Acquired with a Topcon TRC-50DX. 2228 x 1652 pixels. Posterior pole view. Fundus photo. FOV: 50 degrees. Pupil-dilated.
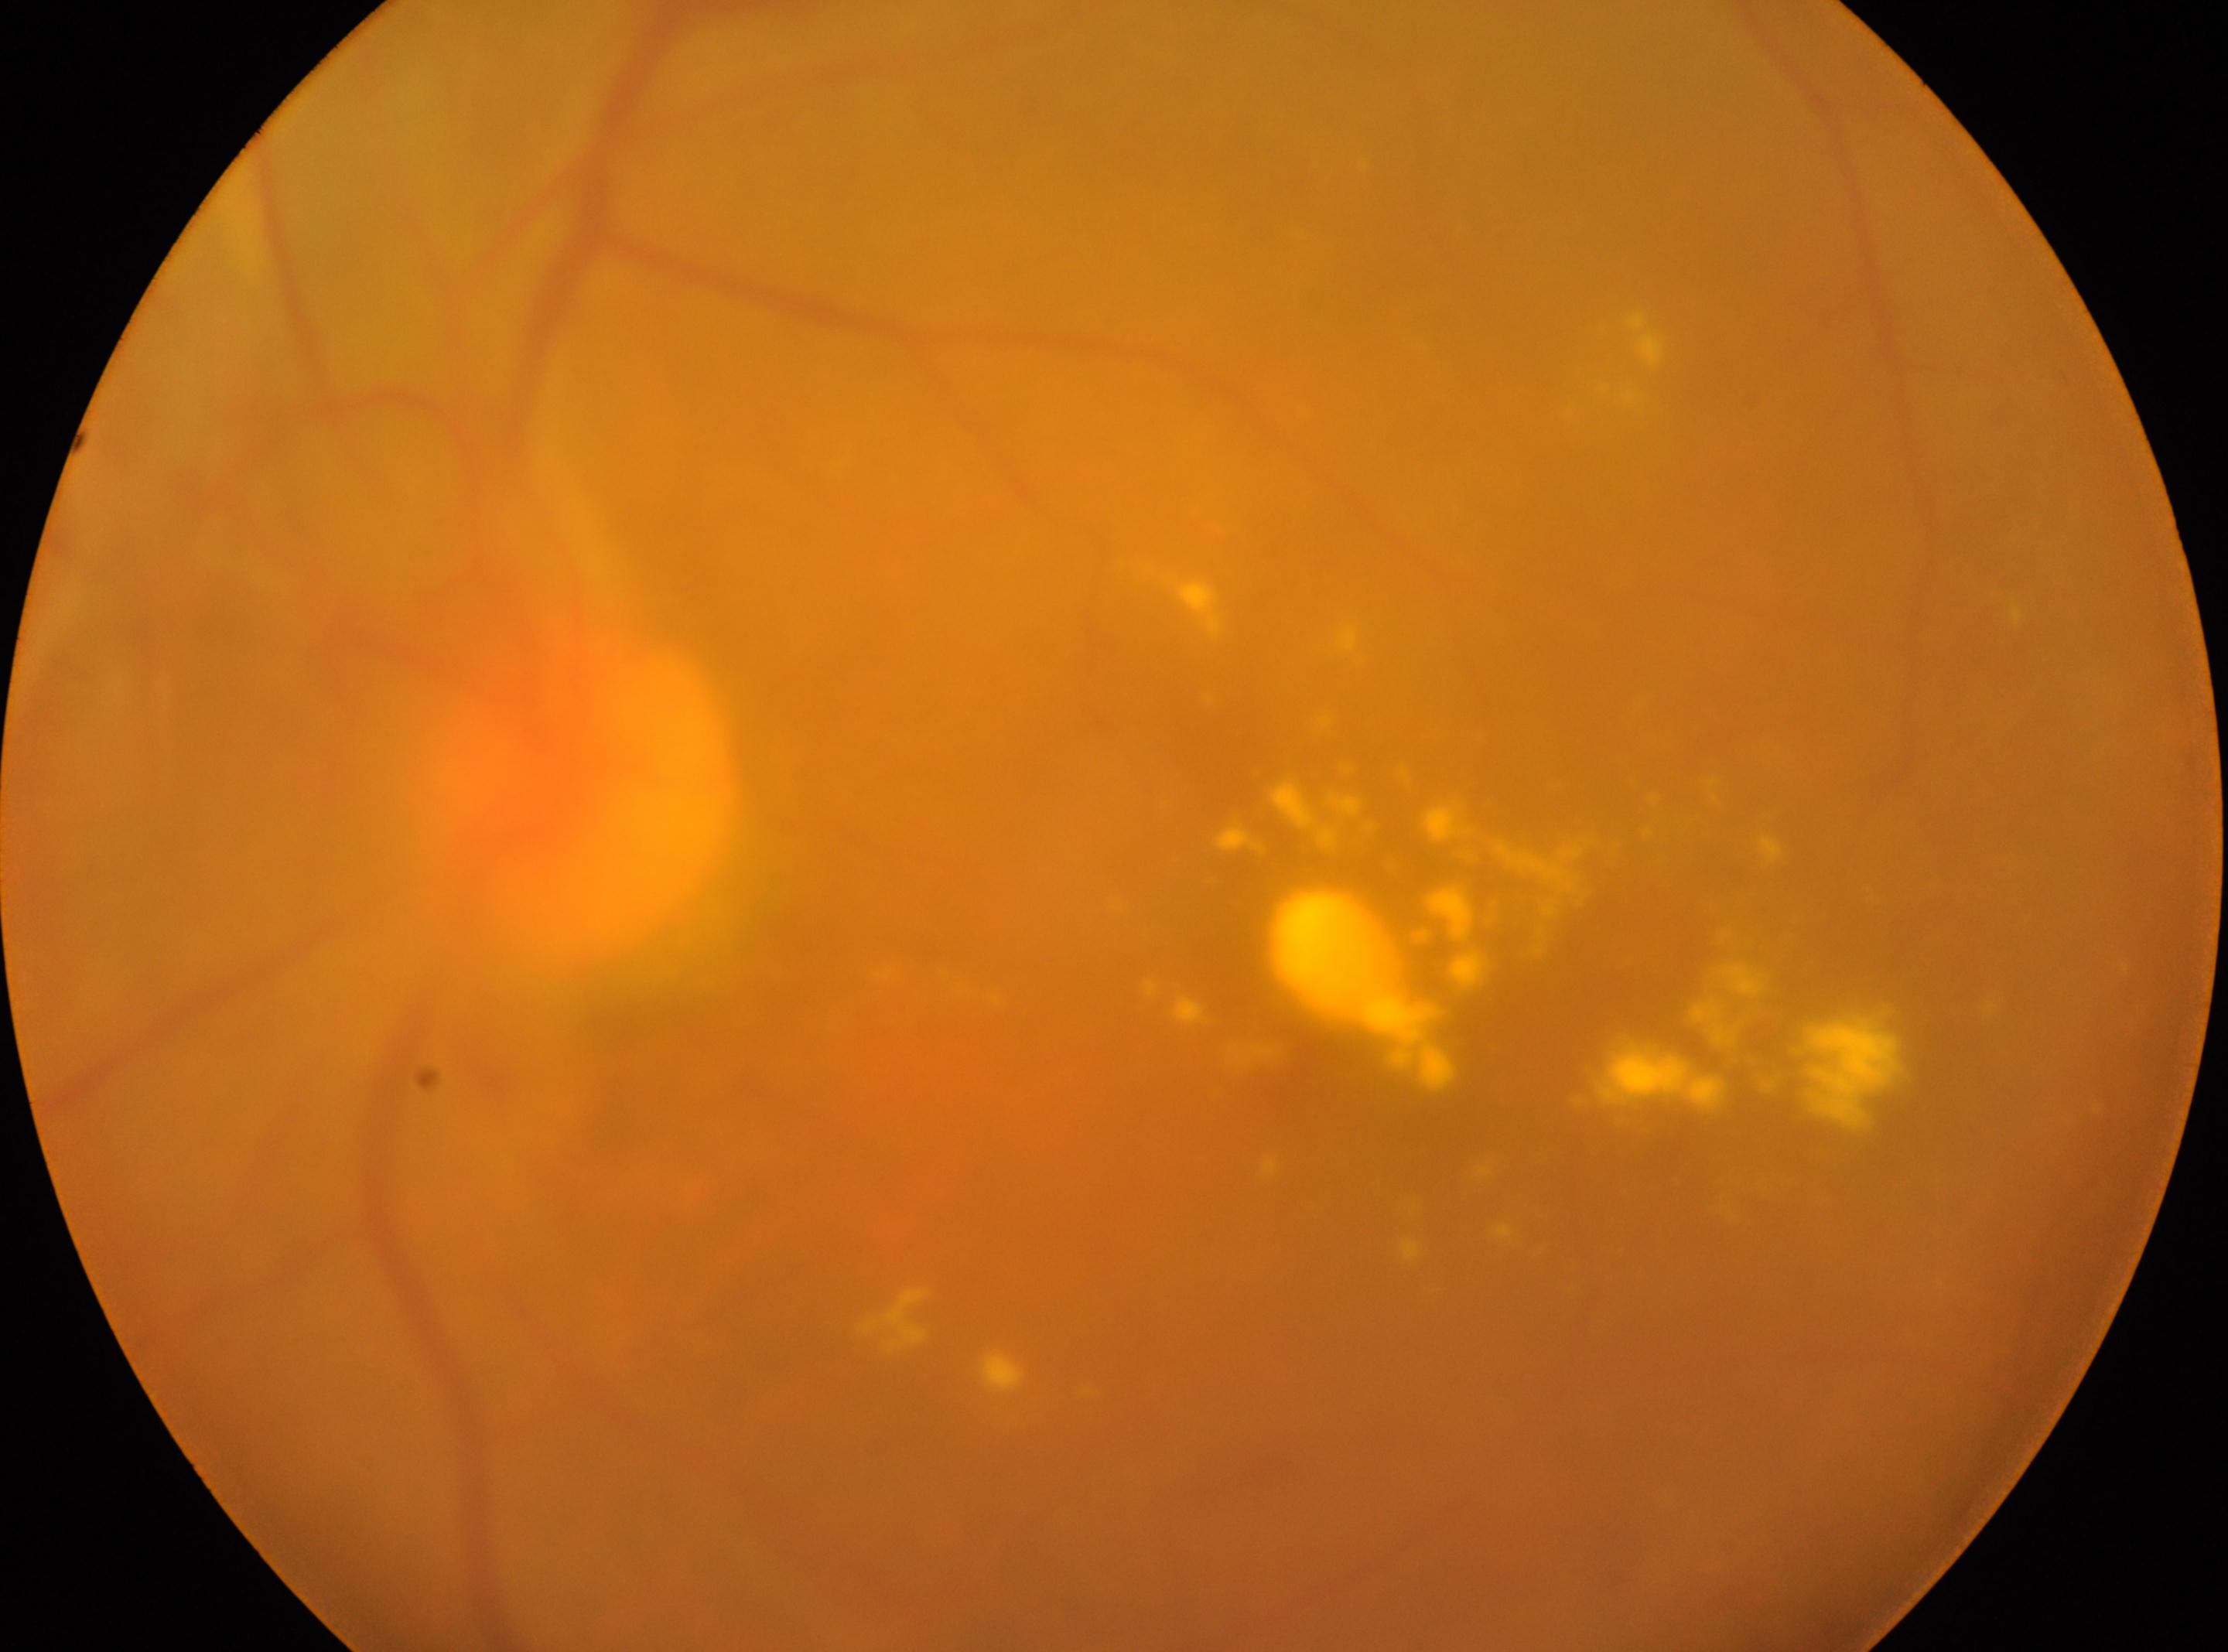

Findings:
* DR stage — moderate NPDR (grade 2)
* optic disc center — 578, 790
* fovea center — 1309, 1039
* laterality — left